Ultra-widefield (UWF) fundus image — 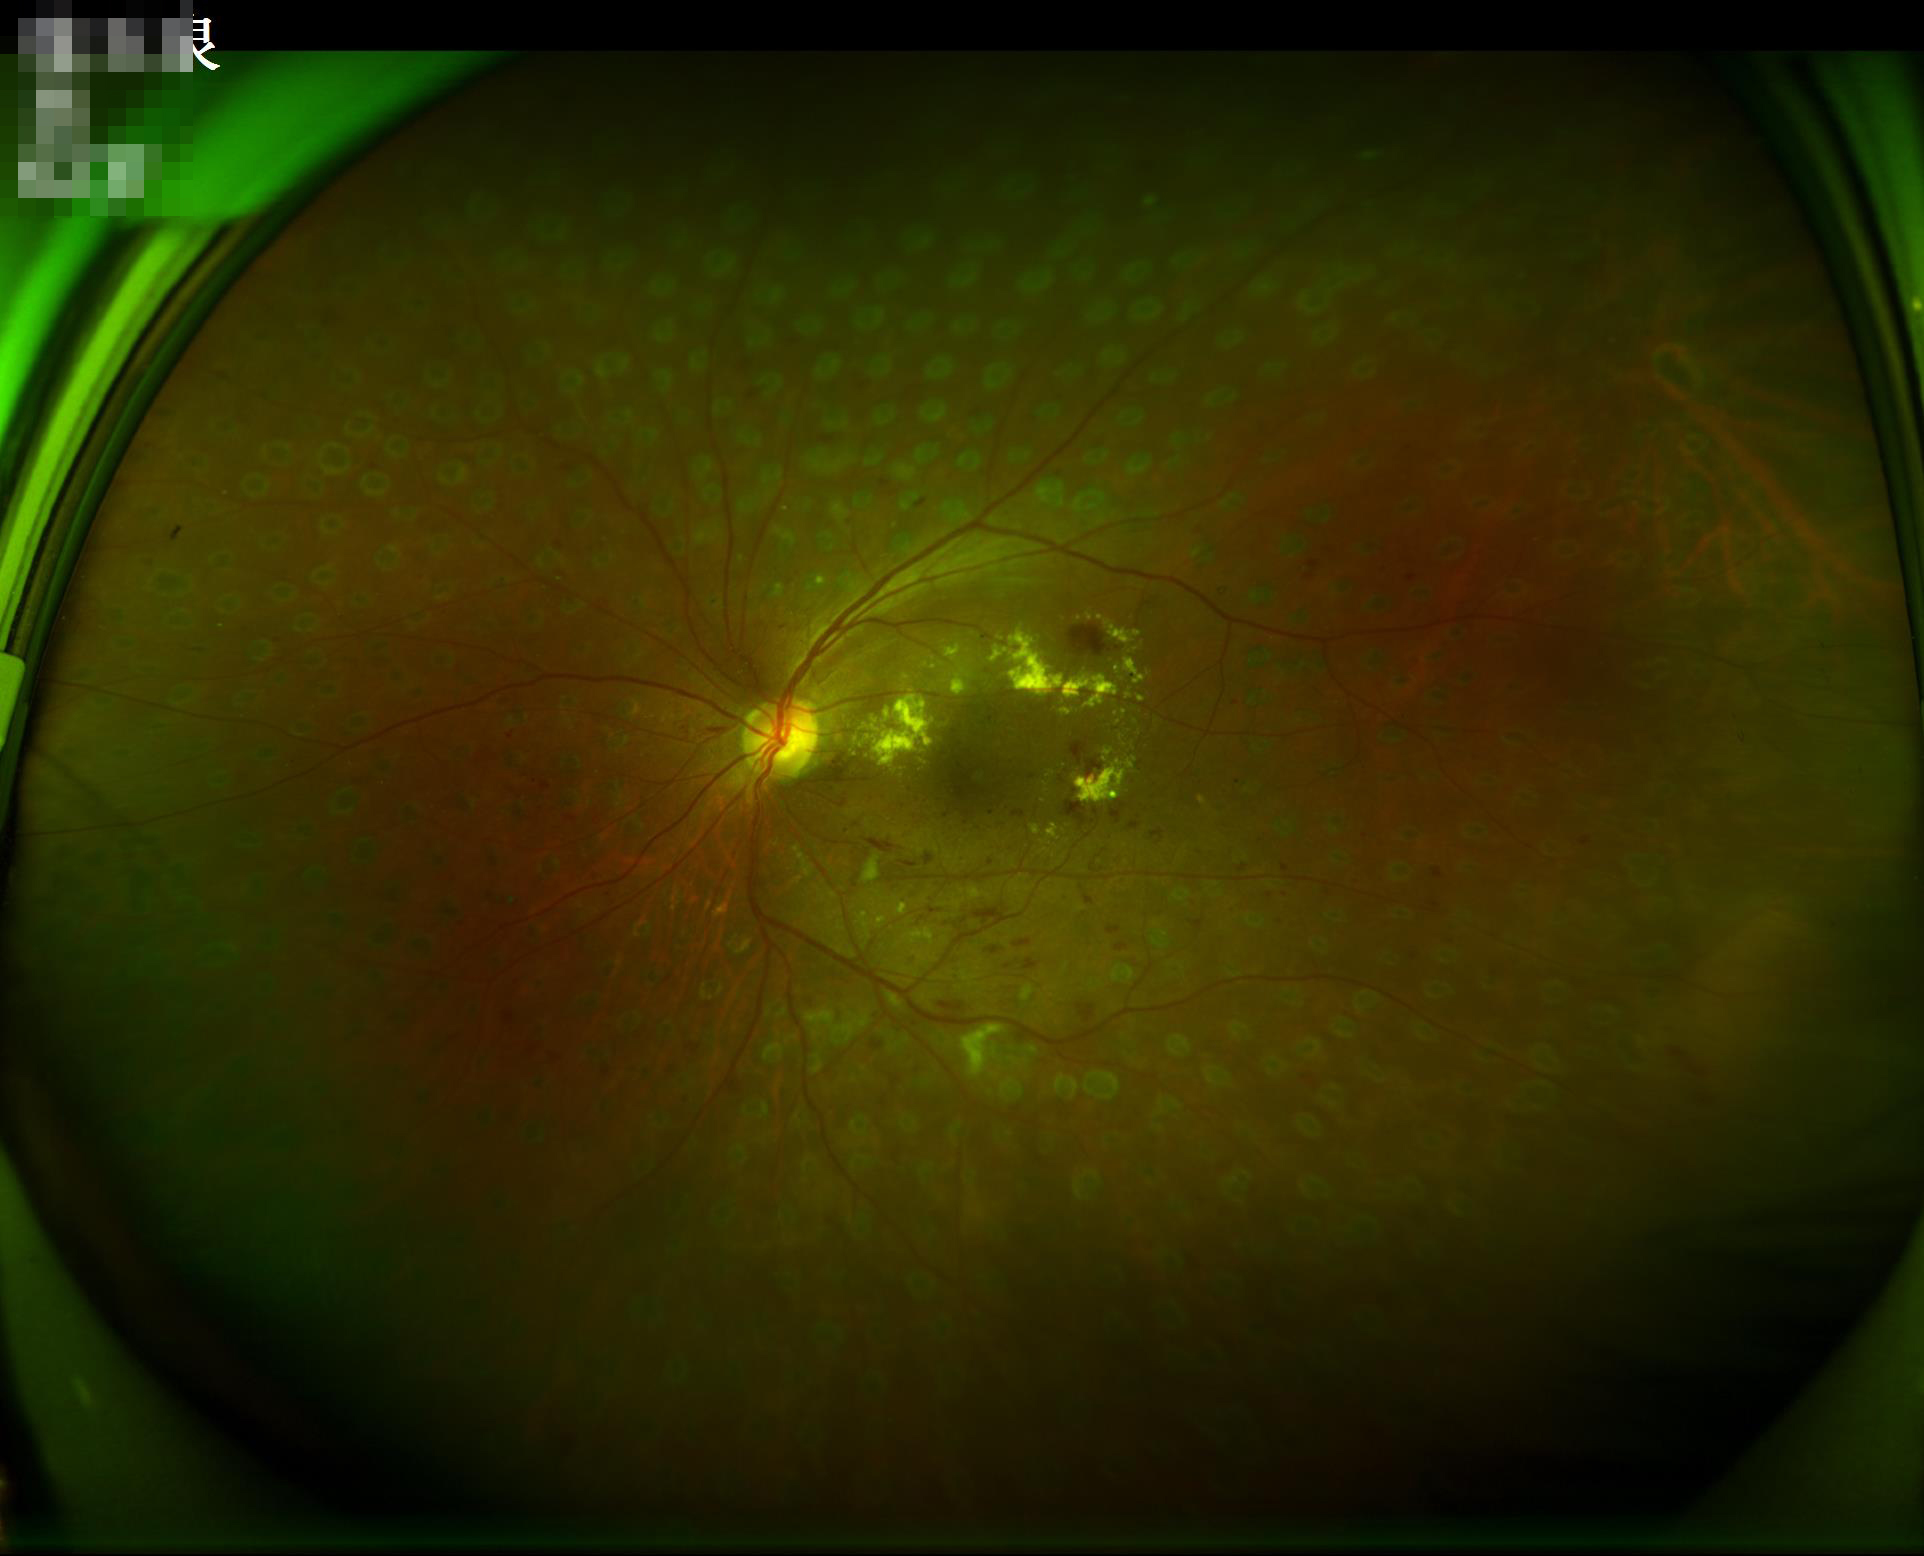 Illumination and color balance are good. Image is sharp throughout the field. Overall quality is good and the image is gradable. Contrast is good.